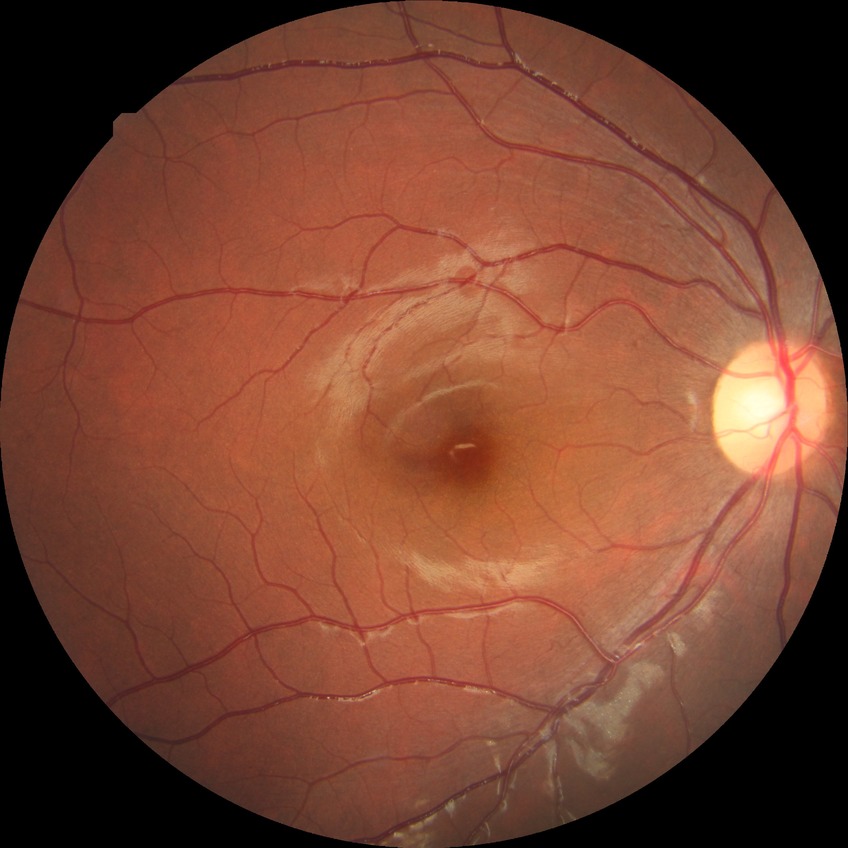 davis_grade: NDR (no diabetic retinopathy)